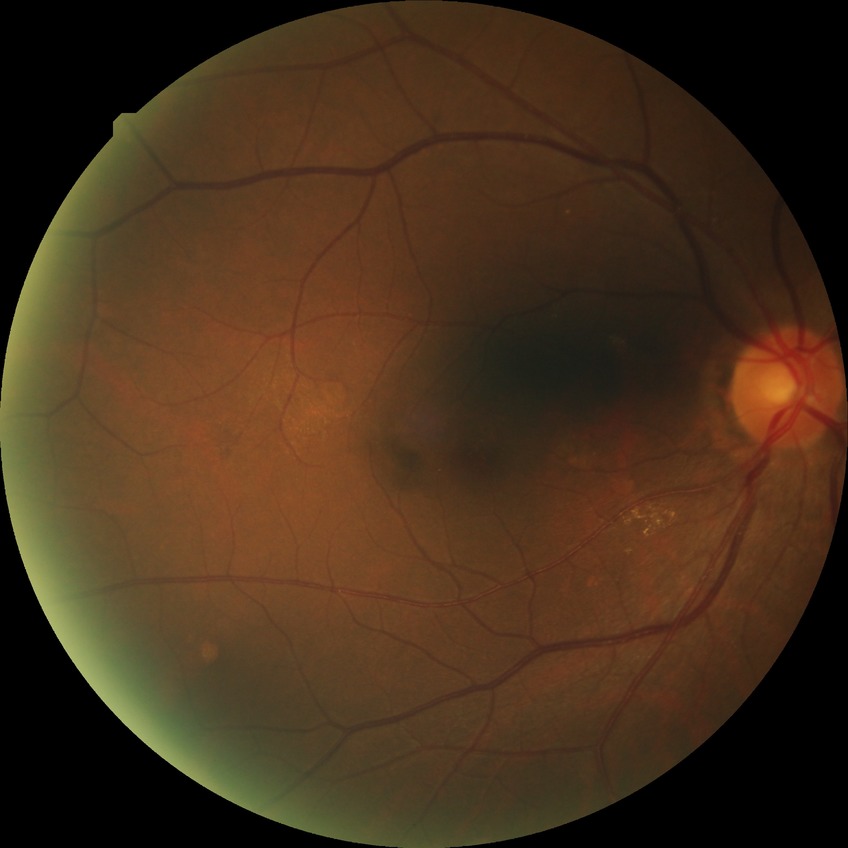 {
  "davis_grade": "no diabetic retinopathy"
}